Wide-field contact fundus photograph of an infant — 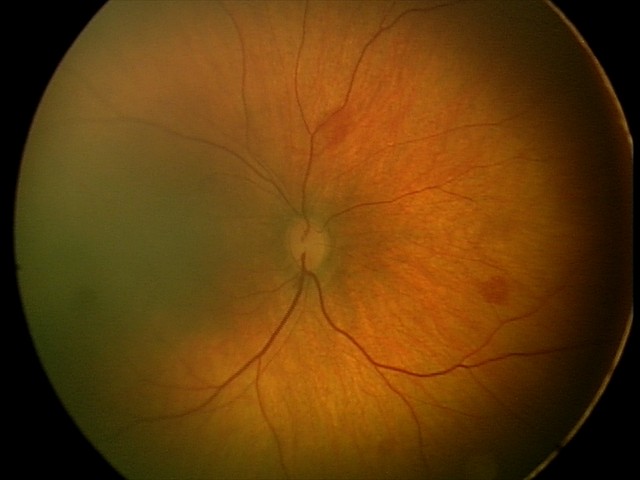 Diagnosis from this screening exam: retinal hemorrhages.